Image size 1536x1152 · 45° field of view · fundus photo: 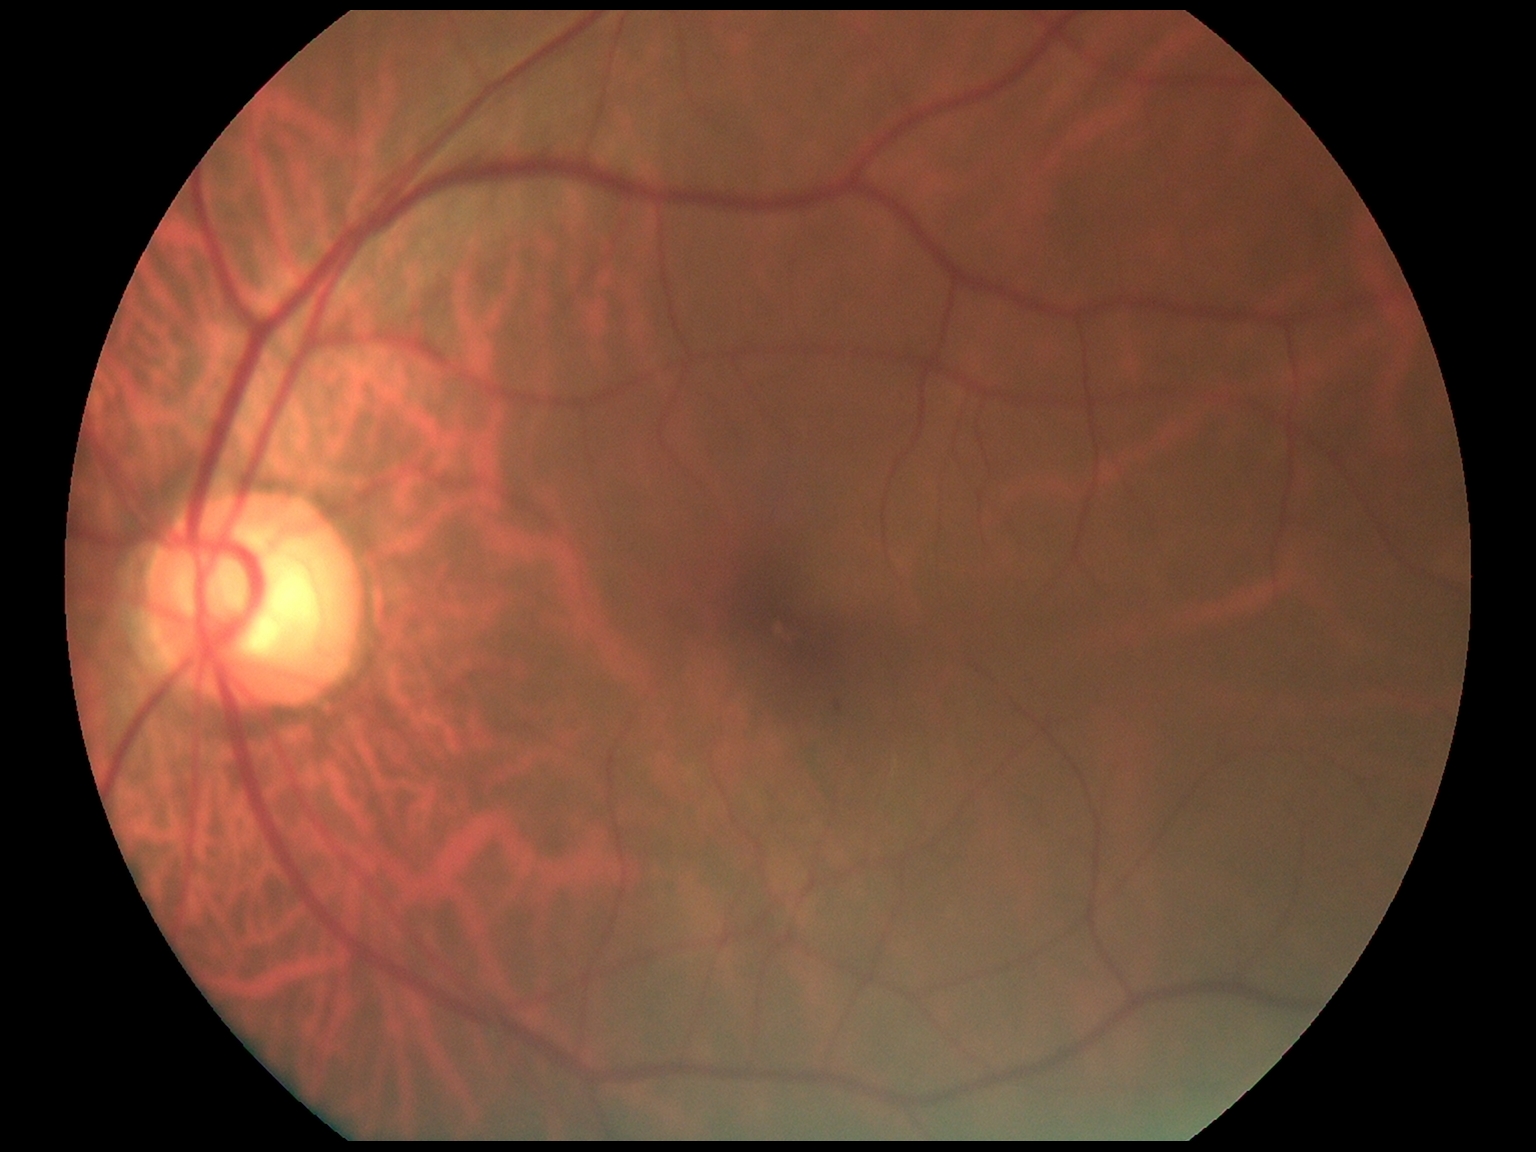 Retinopathy grade is 1/4.